FOV: 50 degrees. Fundus photo — 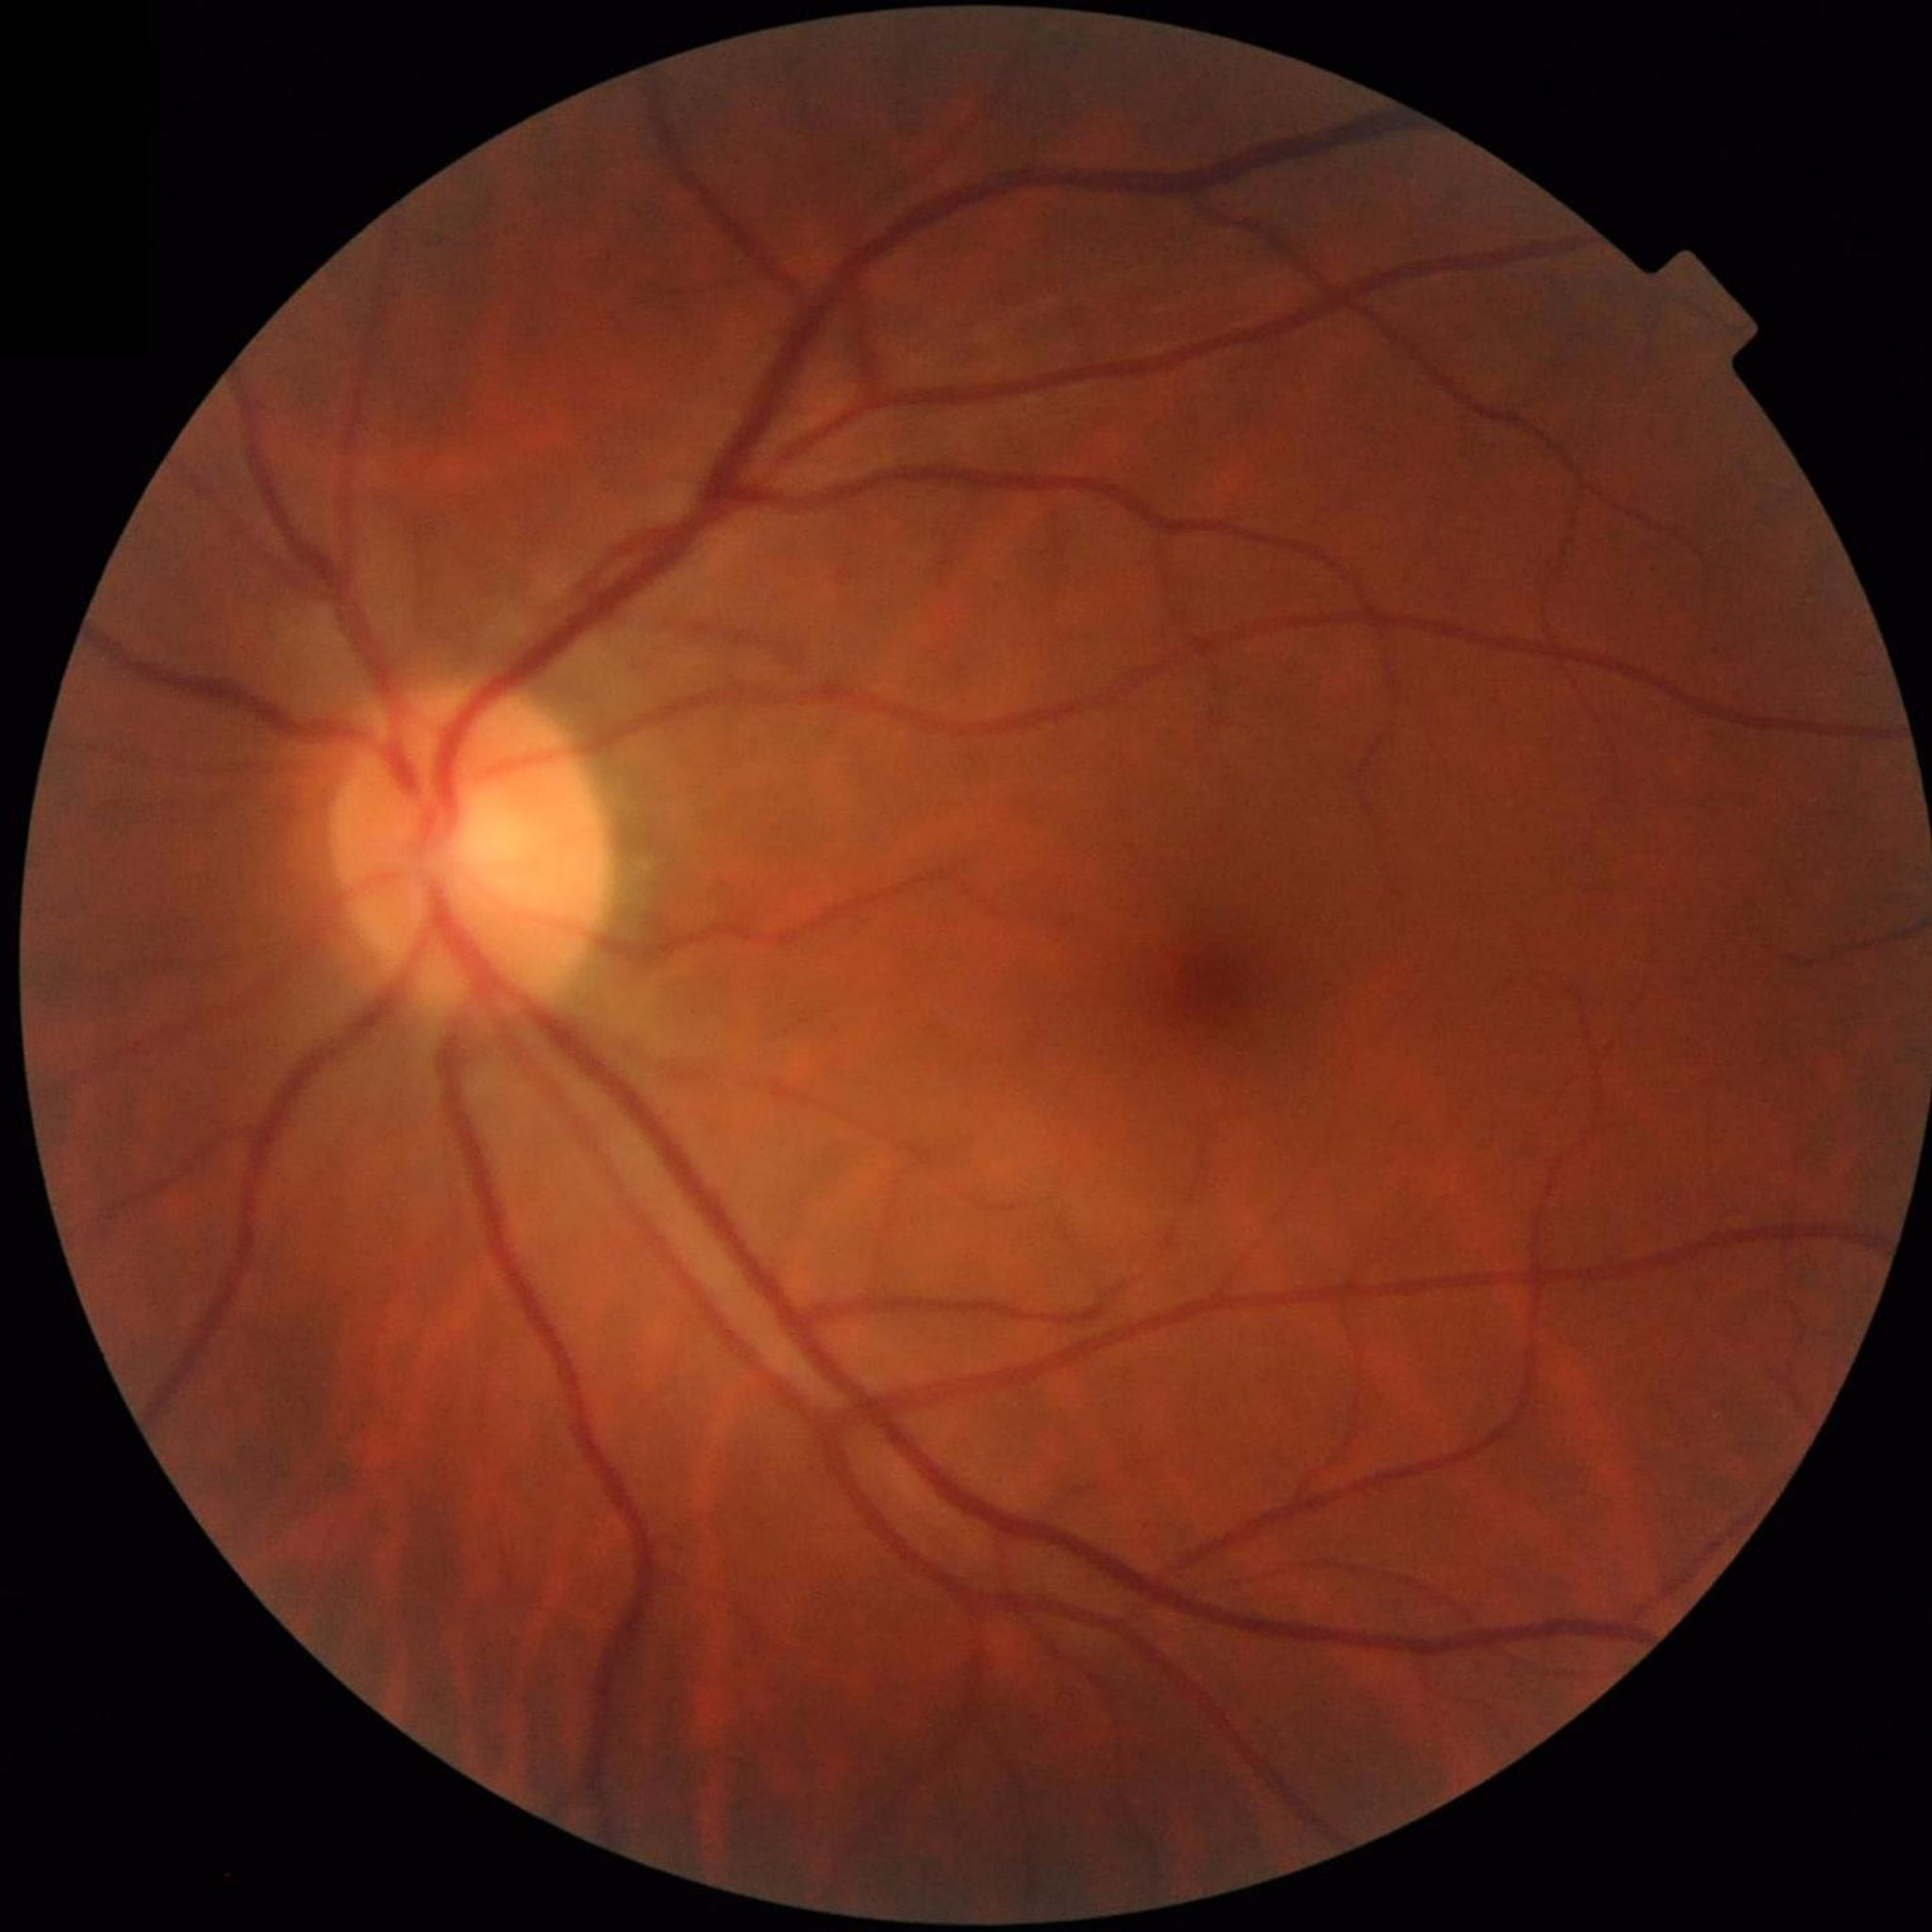 No signs of AMD, diabetic retinopathy, or glaucoma.